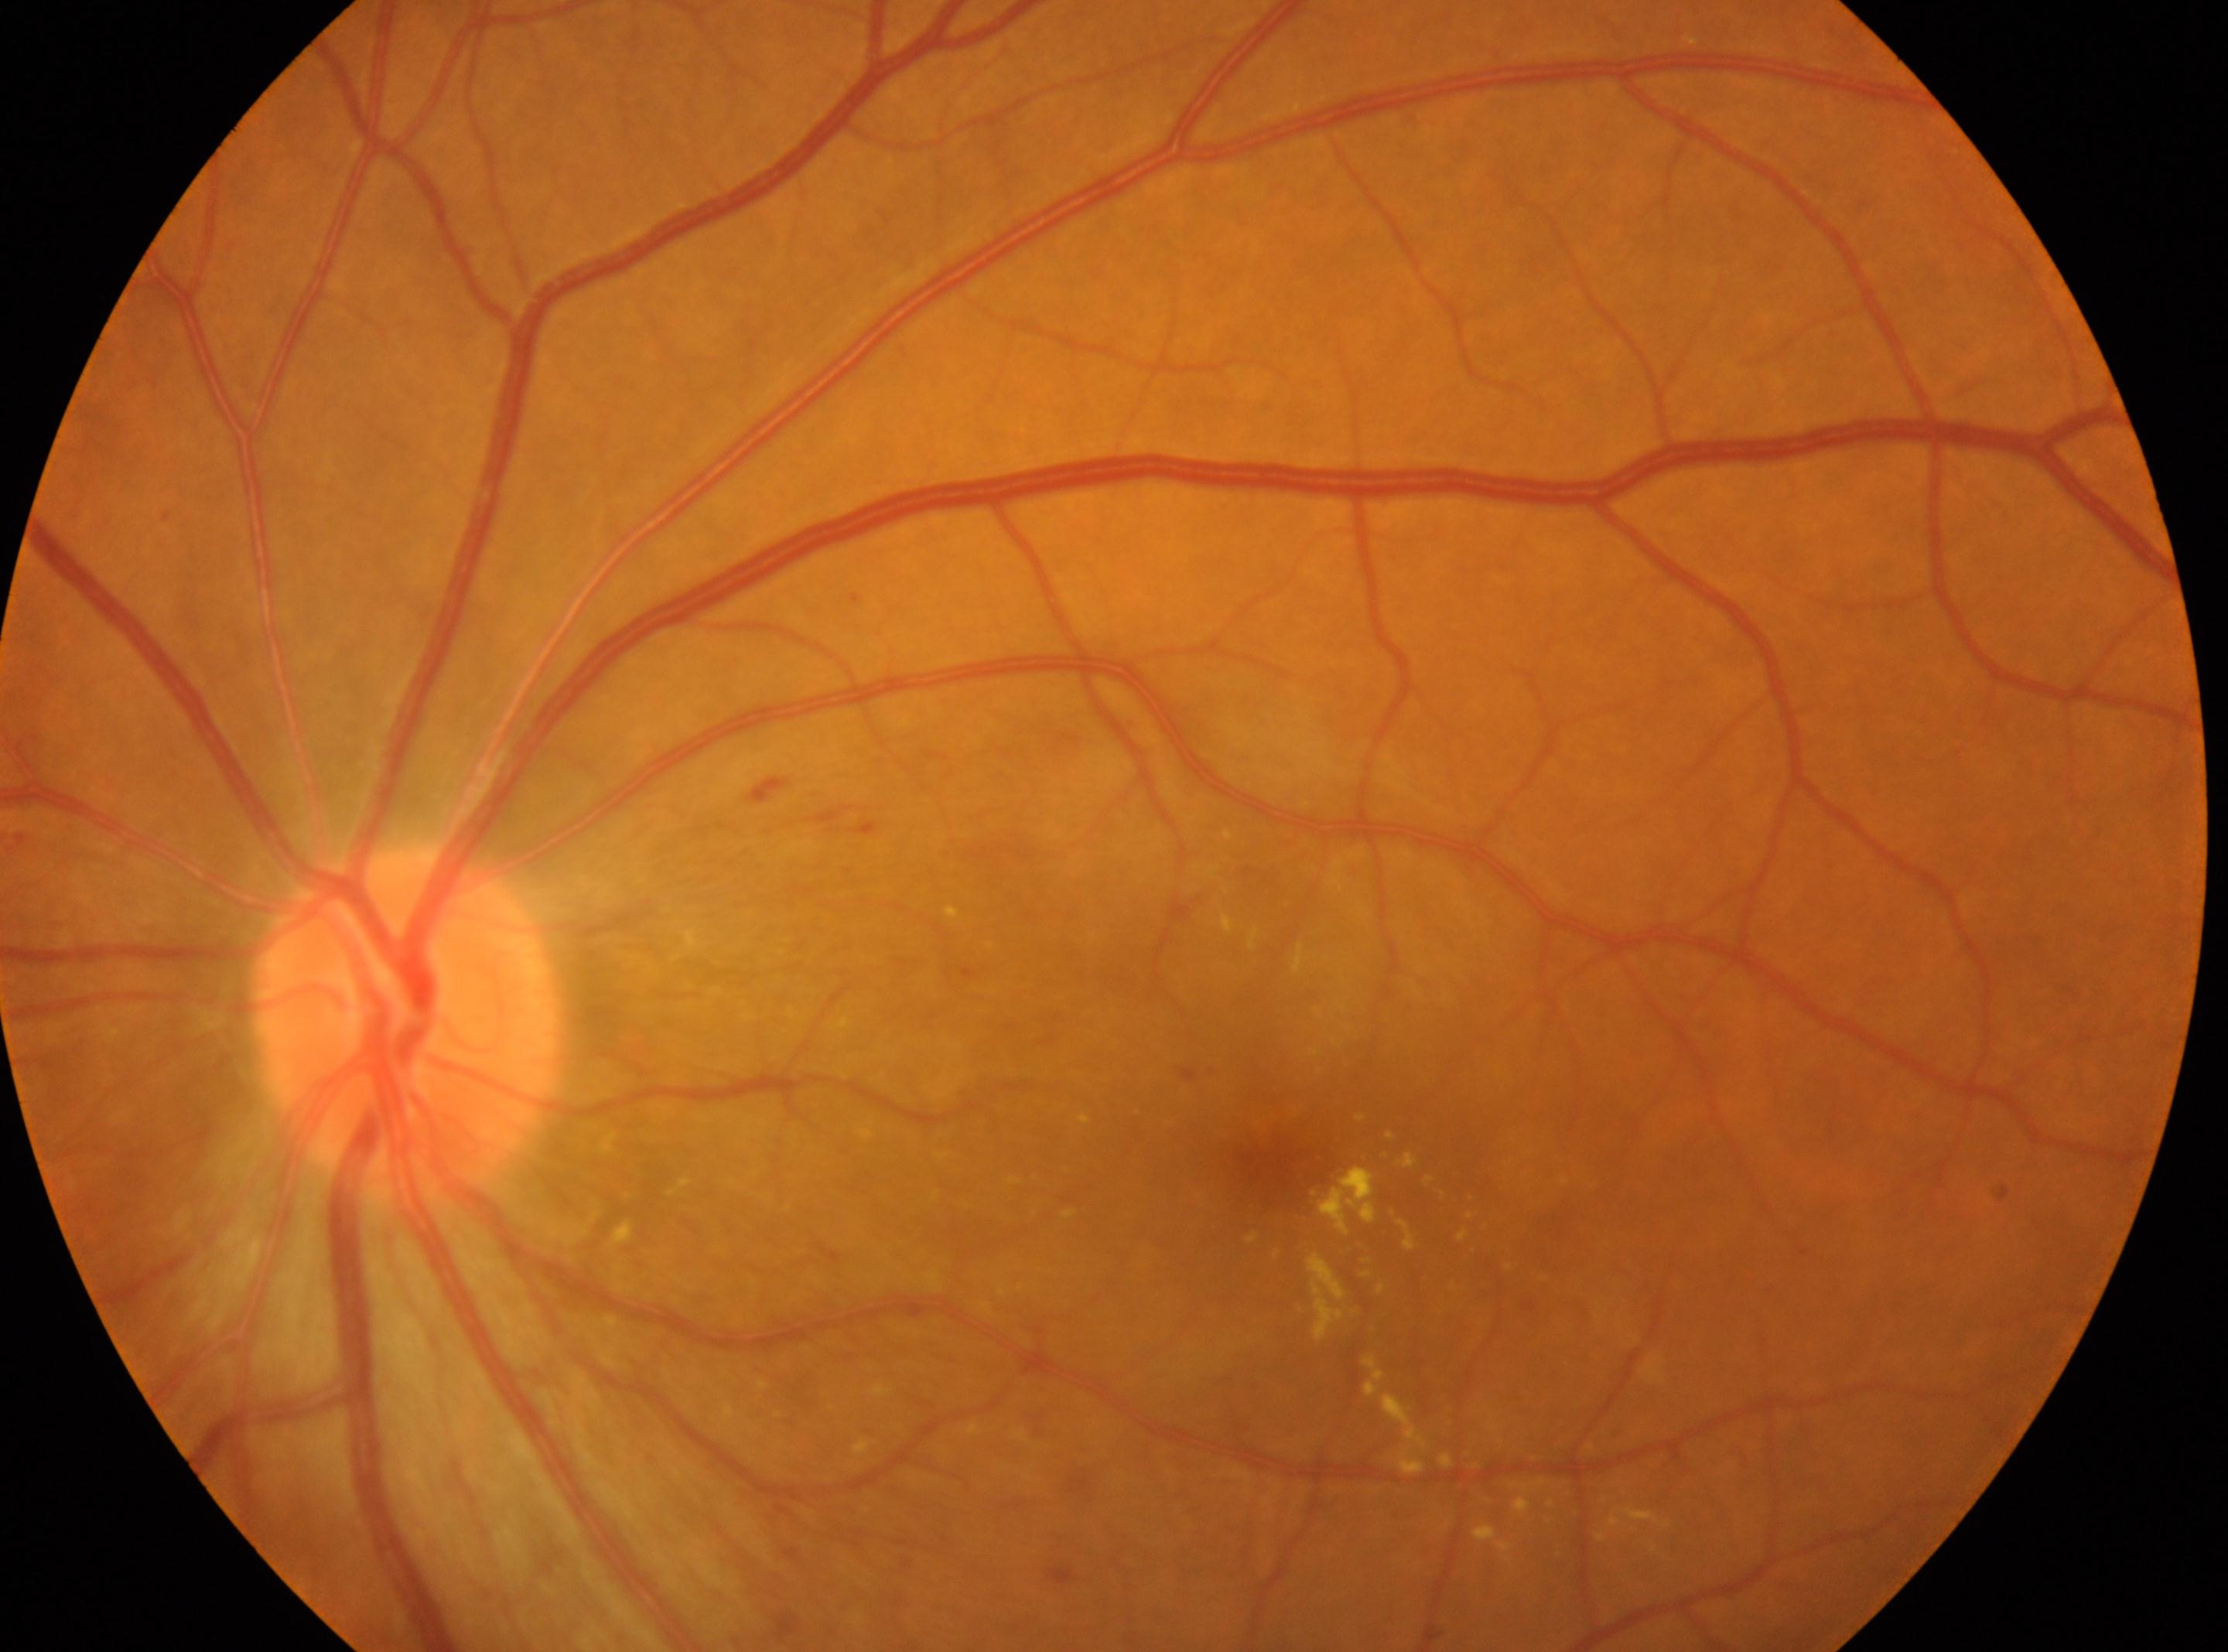 laterality = the left eye, macular center = (1281, 1163), DR class = non-proliferative diabetic retinopathy, optic disc center = (408, 1026), diabetic retinopathy grade = 2.